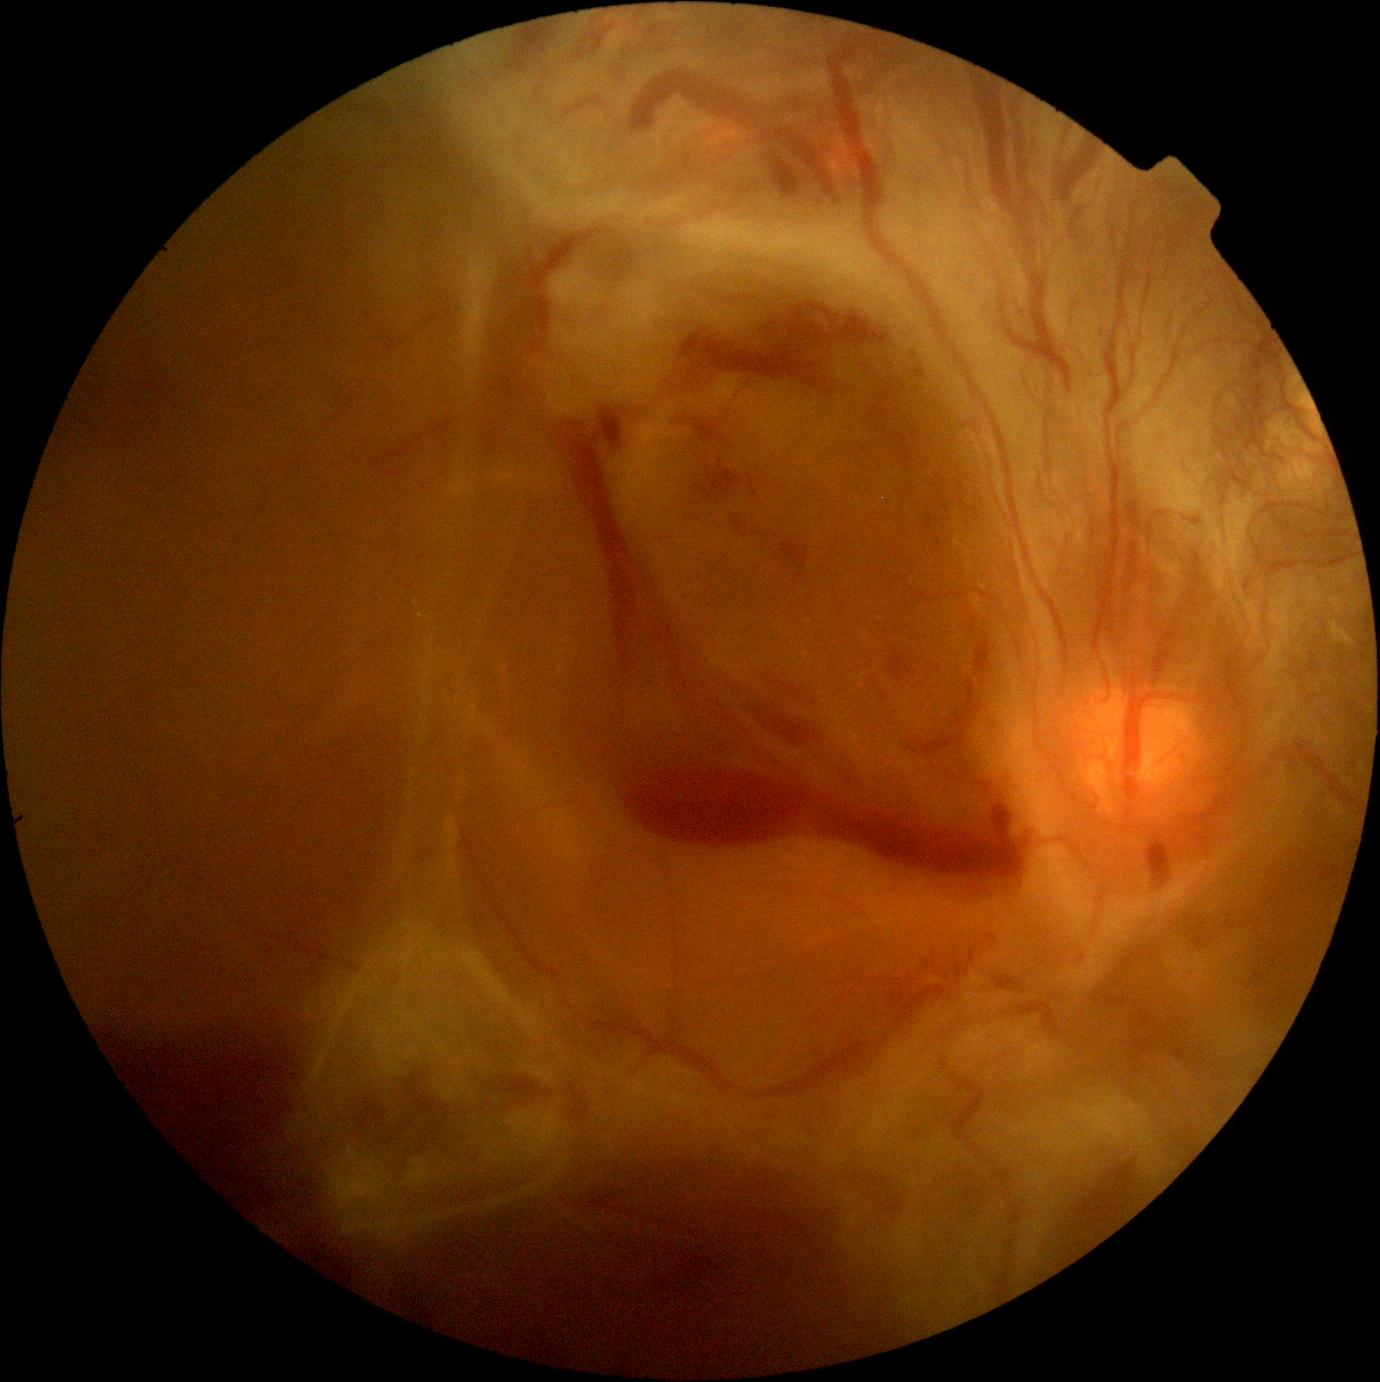 Findings:
– DR grade: 4